50° field of view, acquired with a Topcon TRC-50DX, posterior pole view: 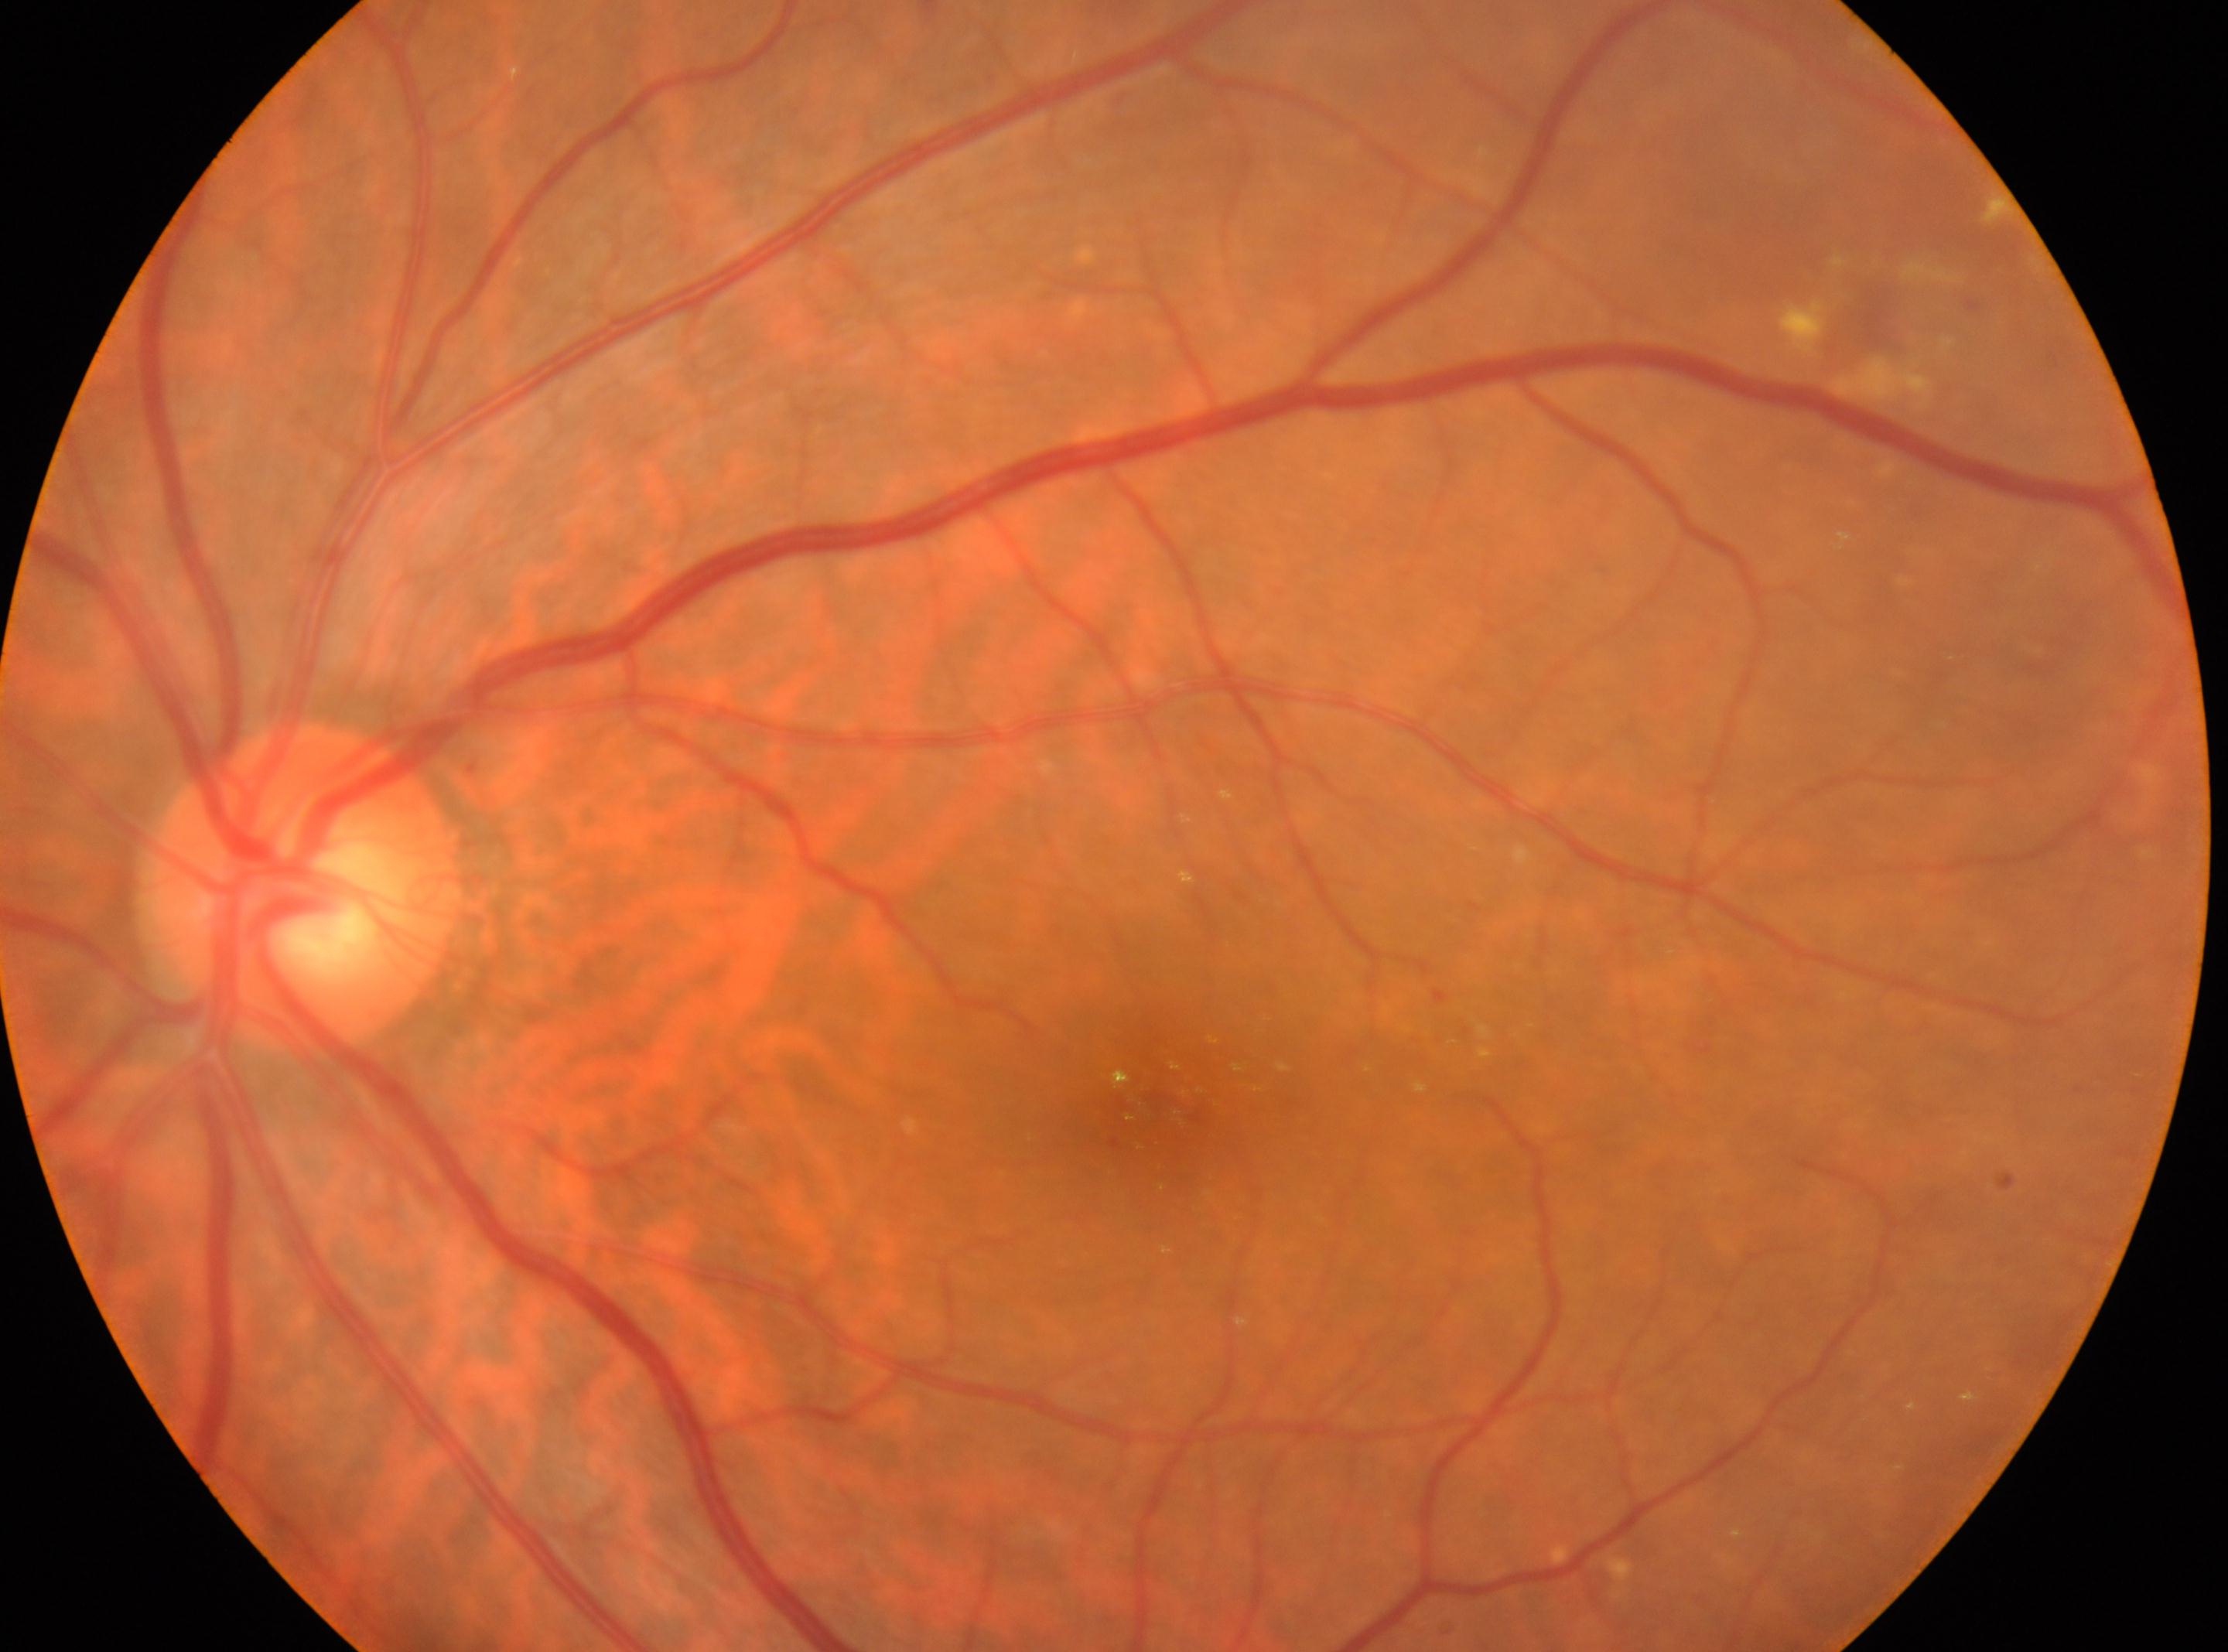 Eye: OS. The fovea center is at 1159, 1112. Optic disc center located at 303, 886. DR severity: moderate NPDR (grade 2).